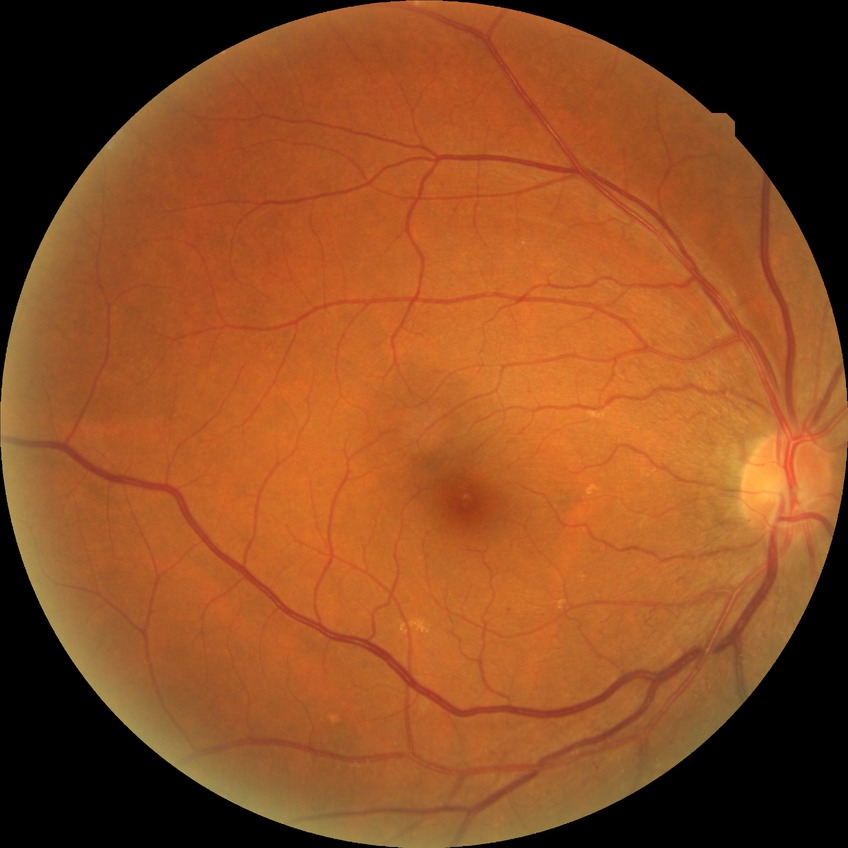 Diabetic retinopathy (DR) is NDR (no diabetic retinopathy).